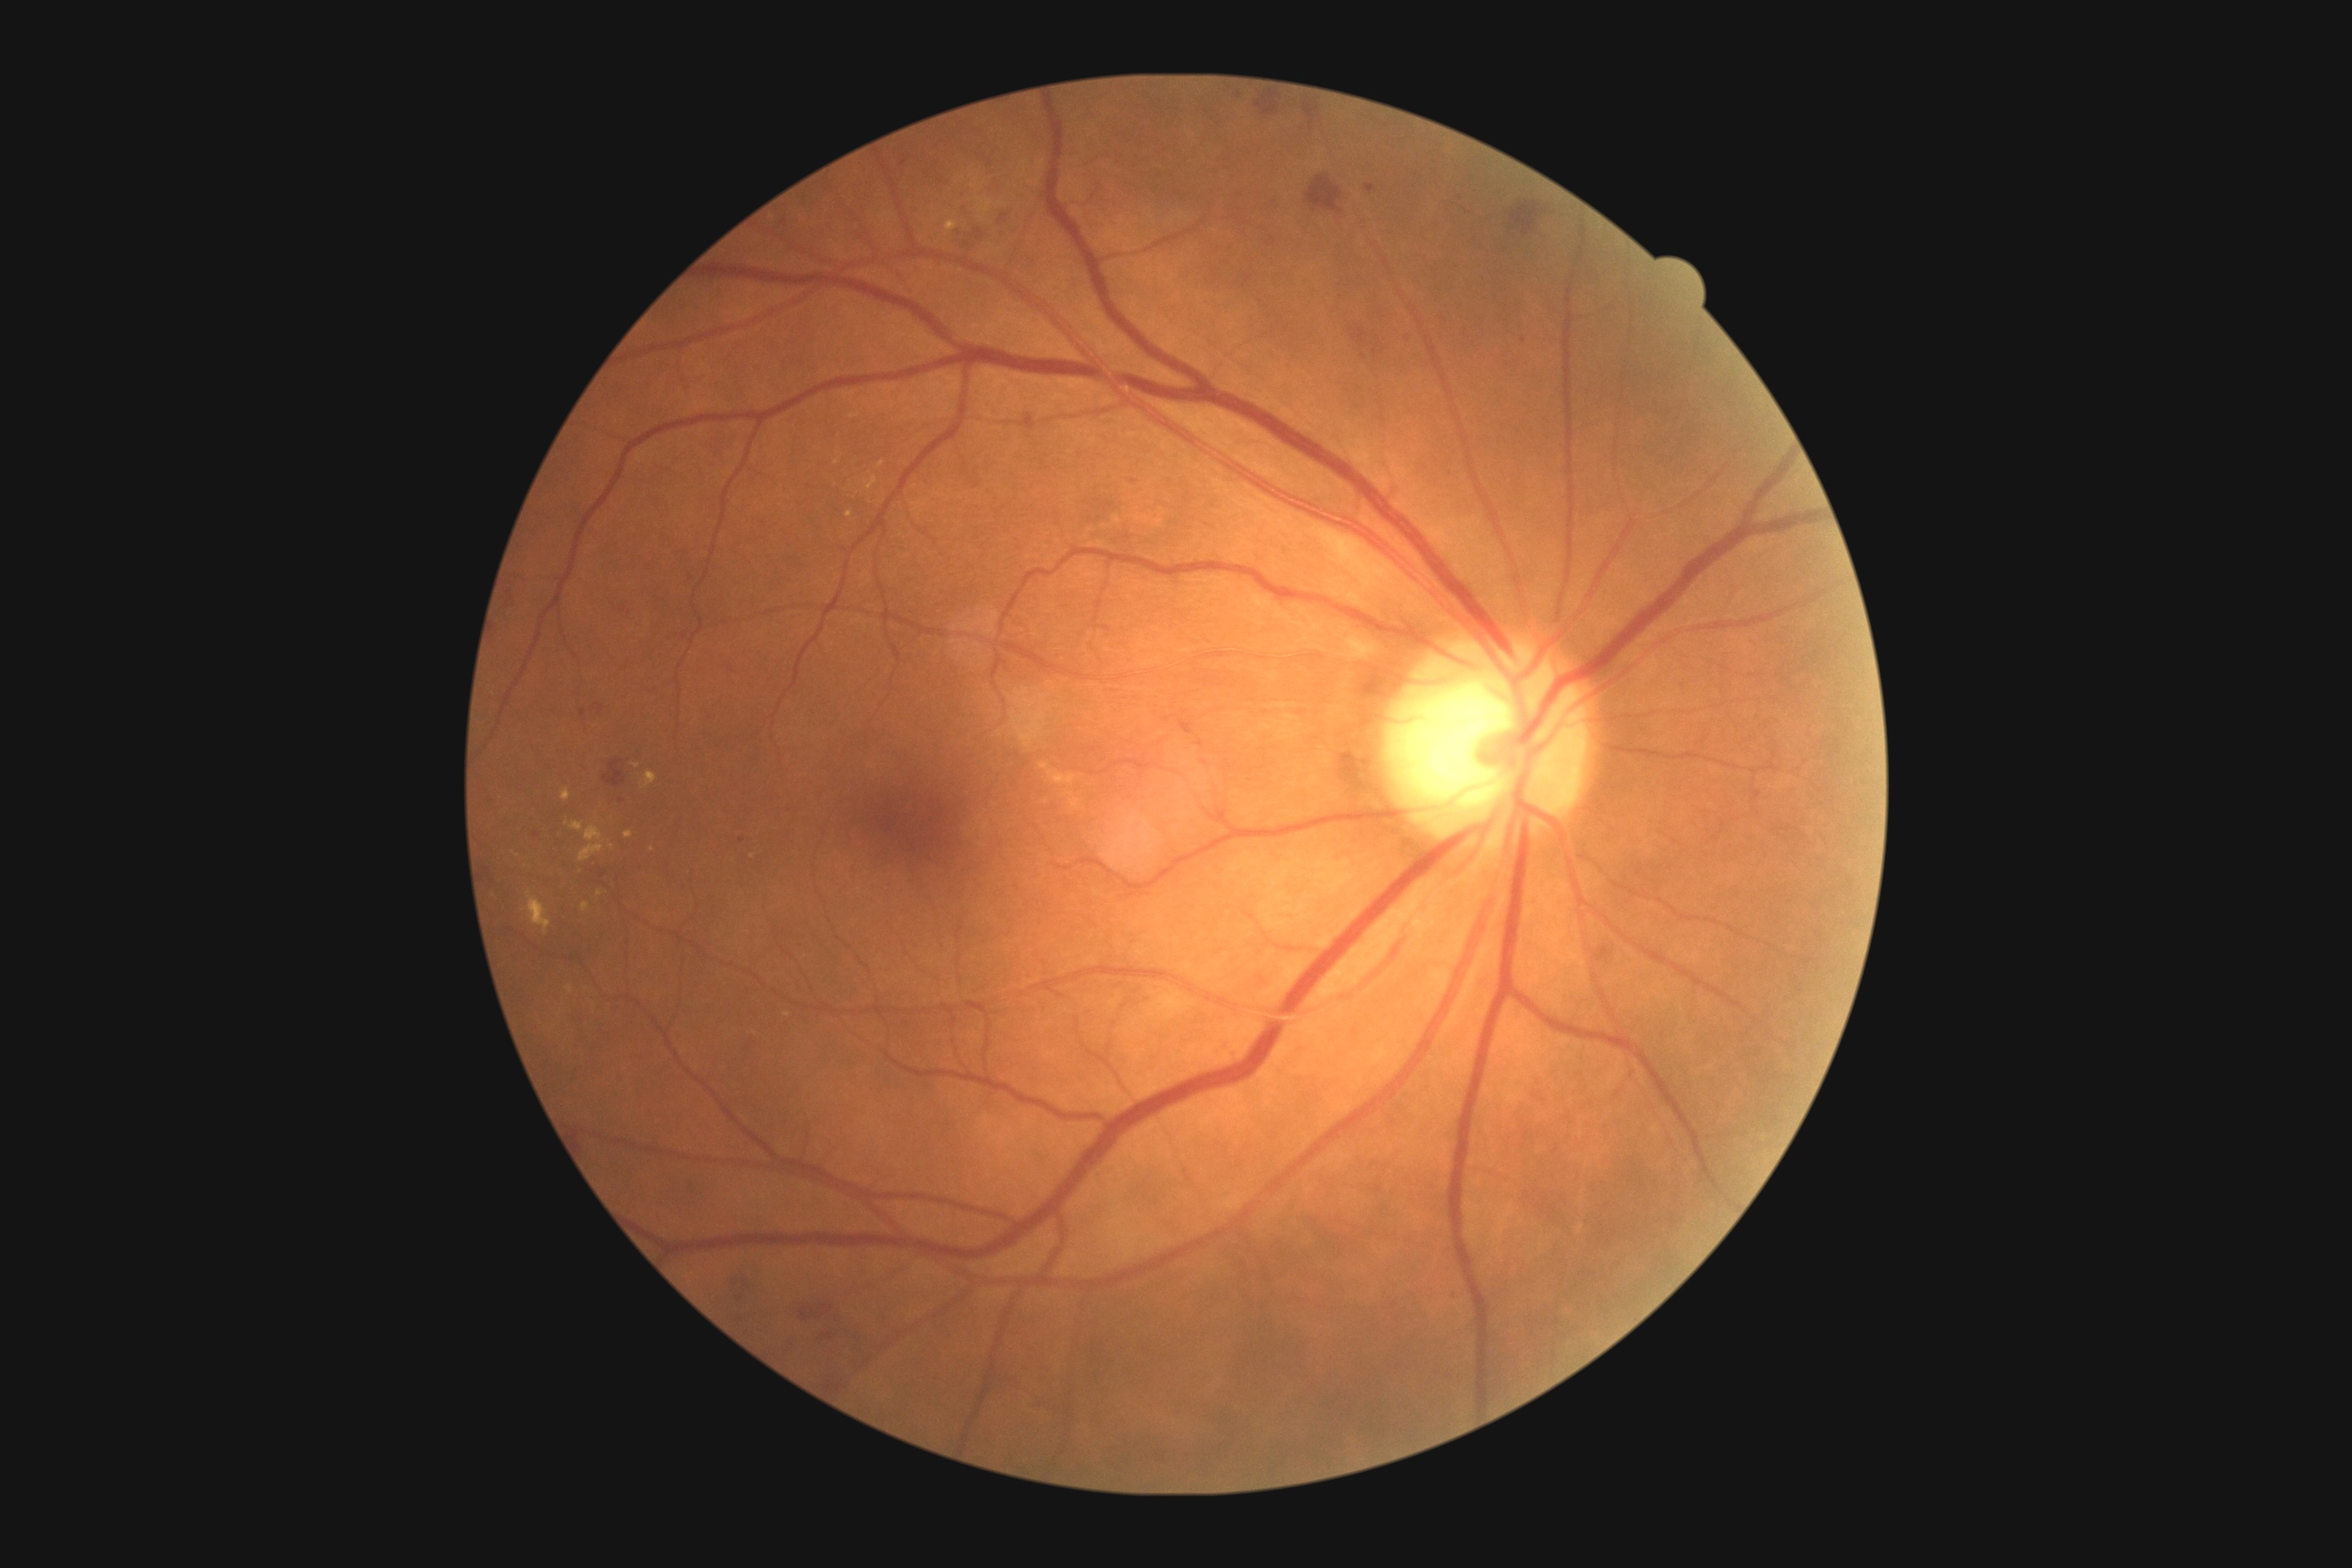

Retinopathy is 2/4
Representative lesions:
hemorrhages (subset): [1596, 946, 1614, 963], [952, 206, 985, 257], [1200, 273, 1215, 286], [805, 480, 812, 491], [1262, 233, 1282, 251], [1250, 92, 1289, 122], [994, 208, 1010, 228], [729, 1275, 756, 1302], [1375, 1184, 1382, 1193], [614, 1075, 625, 1084], [1447, 1289, 1458, 1302], [852, 455, 865, 475]
Small hemorrhages approximately at [x=603, y=873], [x=1205, y=762], [x=990, y=163], [x=1200, y=744]